Fundus photo; image size 240x240.
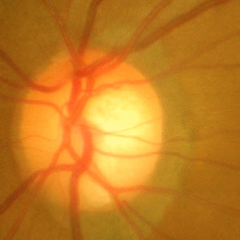 Advanced glaucoma.